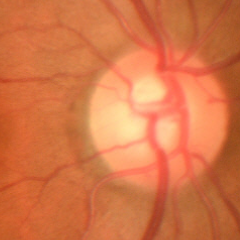 Q: What is the glaucoma diagnosis?
A: No glaucoma.